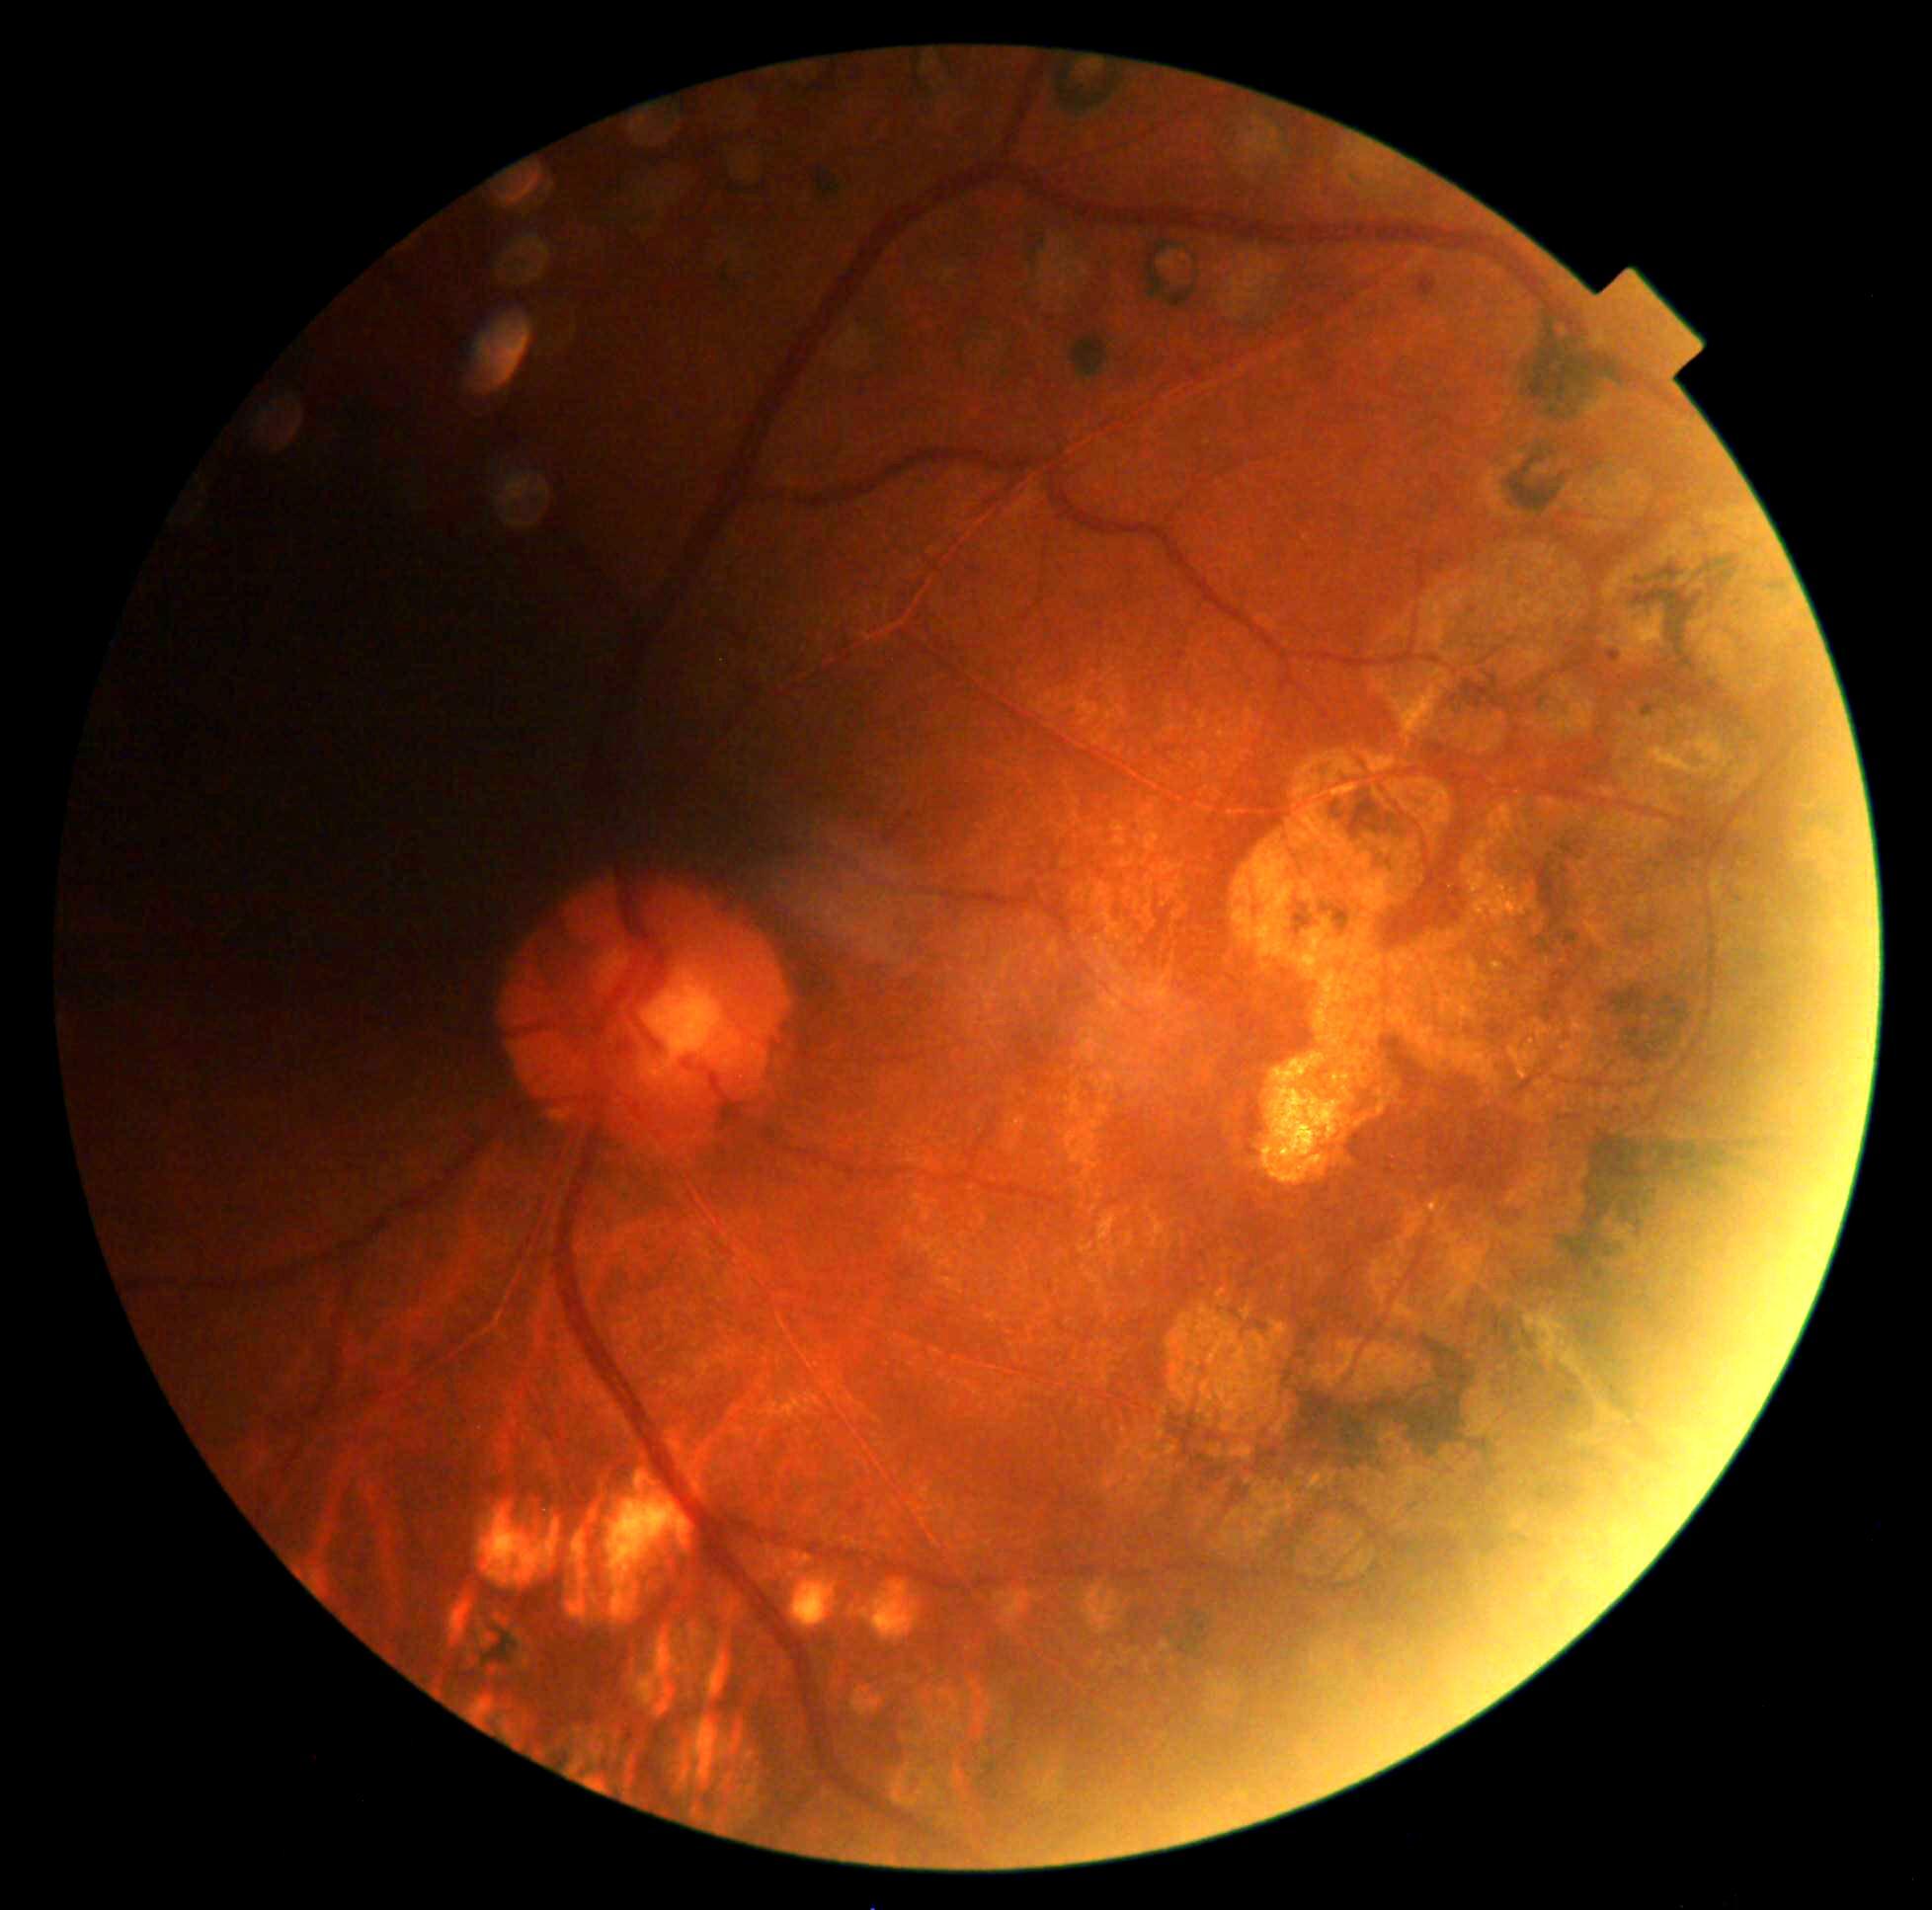 Retinopathy is mild non-proliferative diabetic retinopathy (grade 1). The retinopathy is classified as non-proliferative diabetic retinopathy.